CFP · 2102x1736:
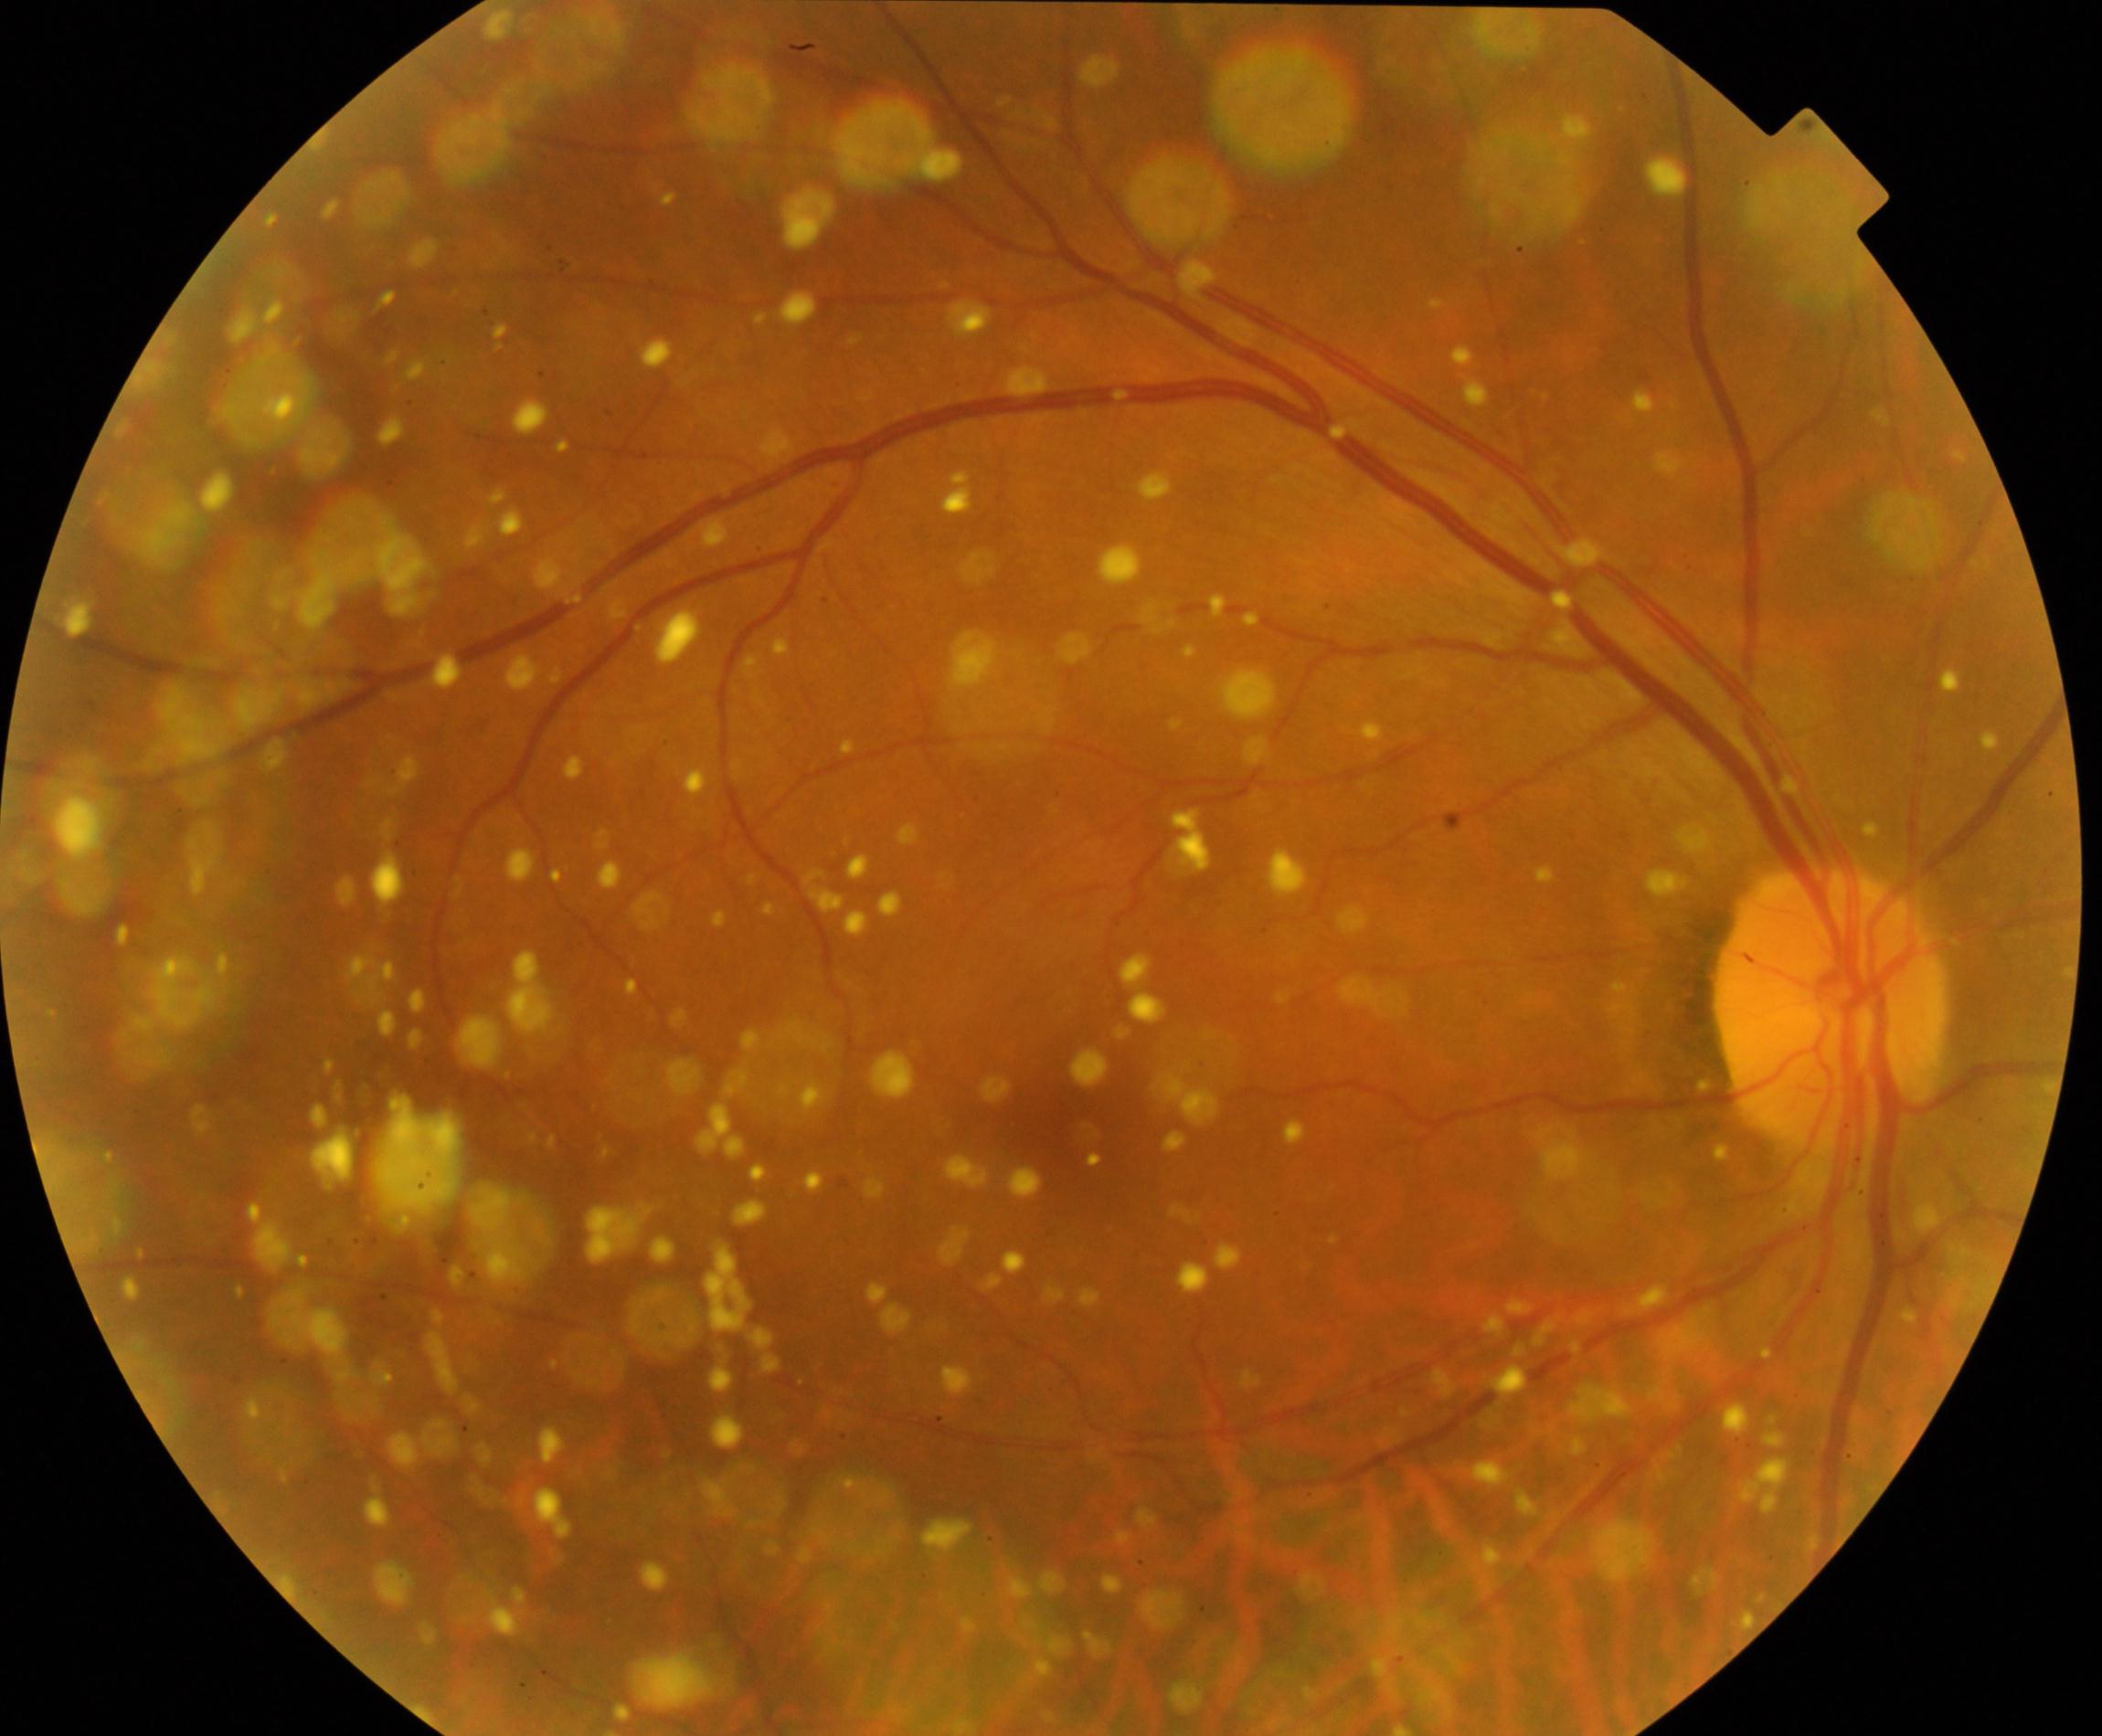
There is evidence of vitreous particles. Characterized by vitreous opacities including asteroid hyalosis, synchysis scintillans, and deposits of familial amyloidosis.